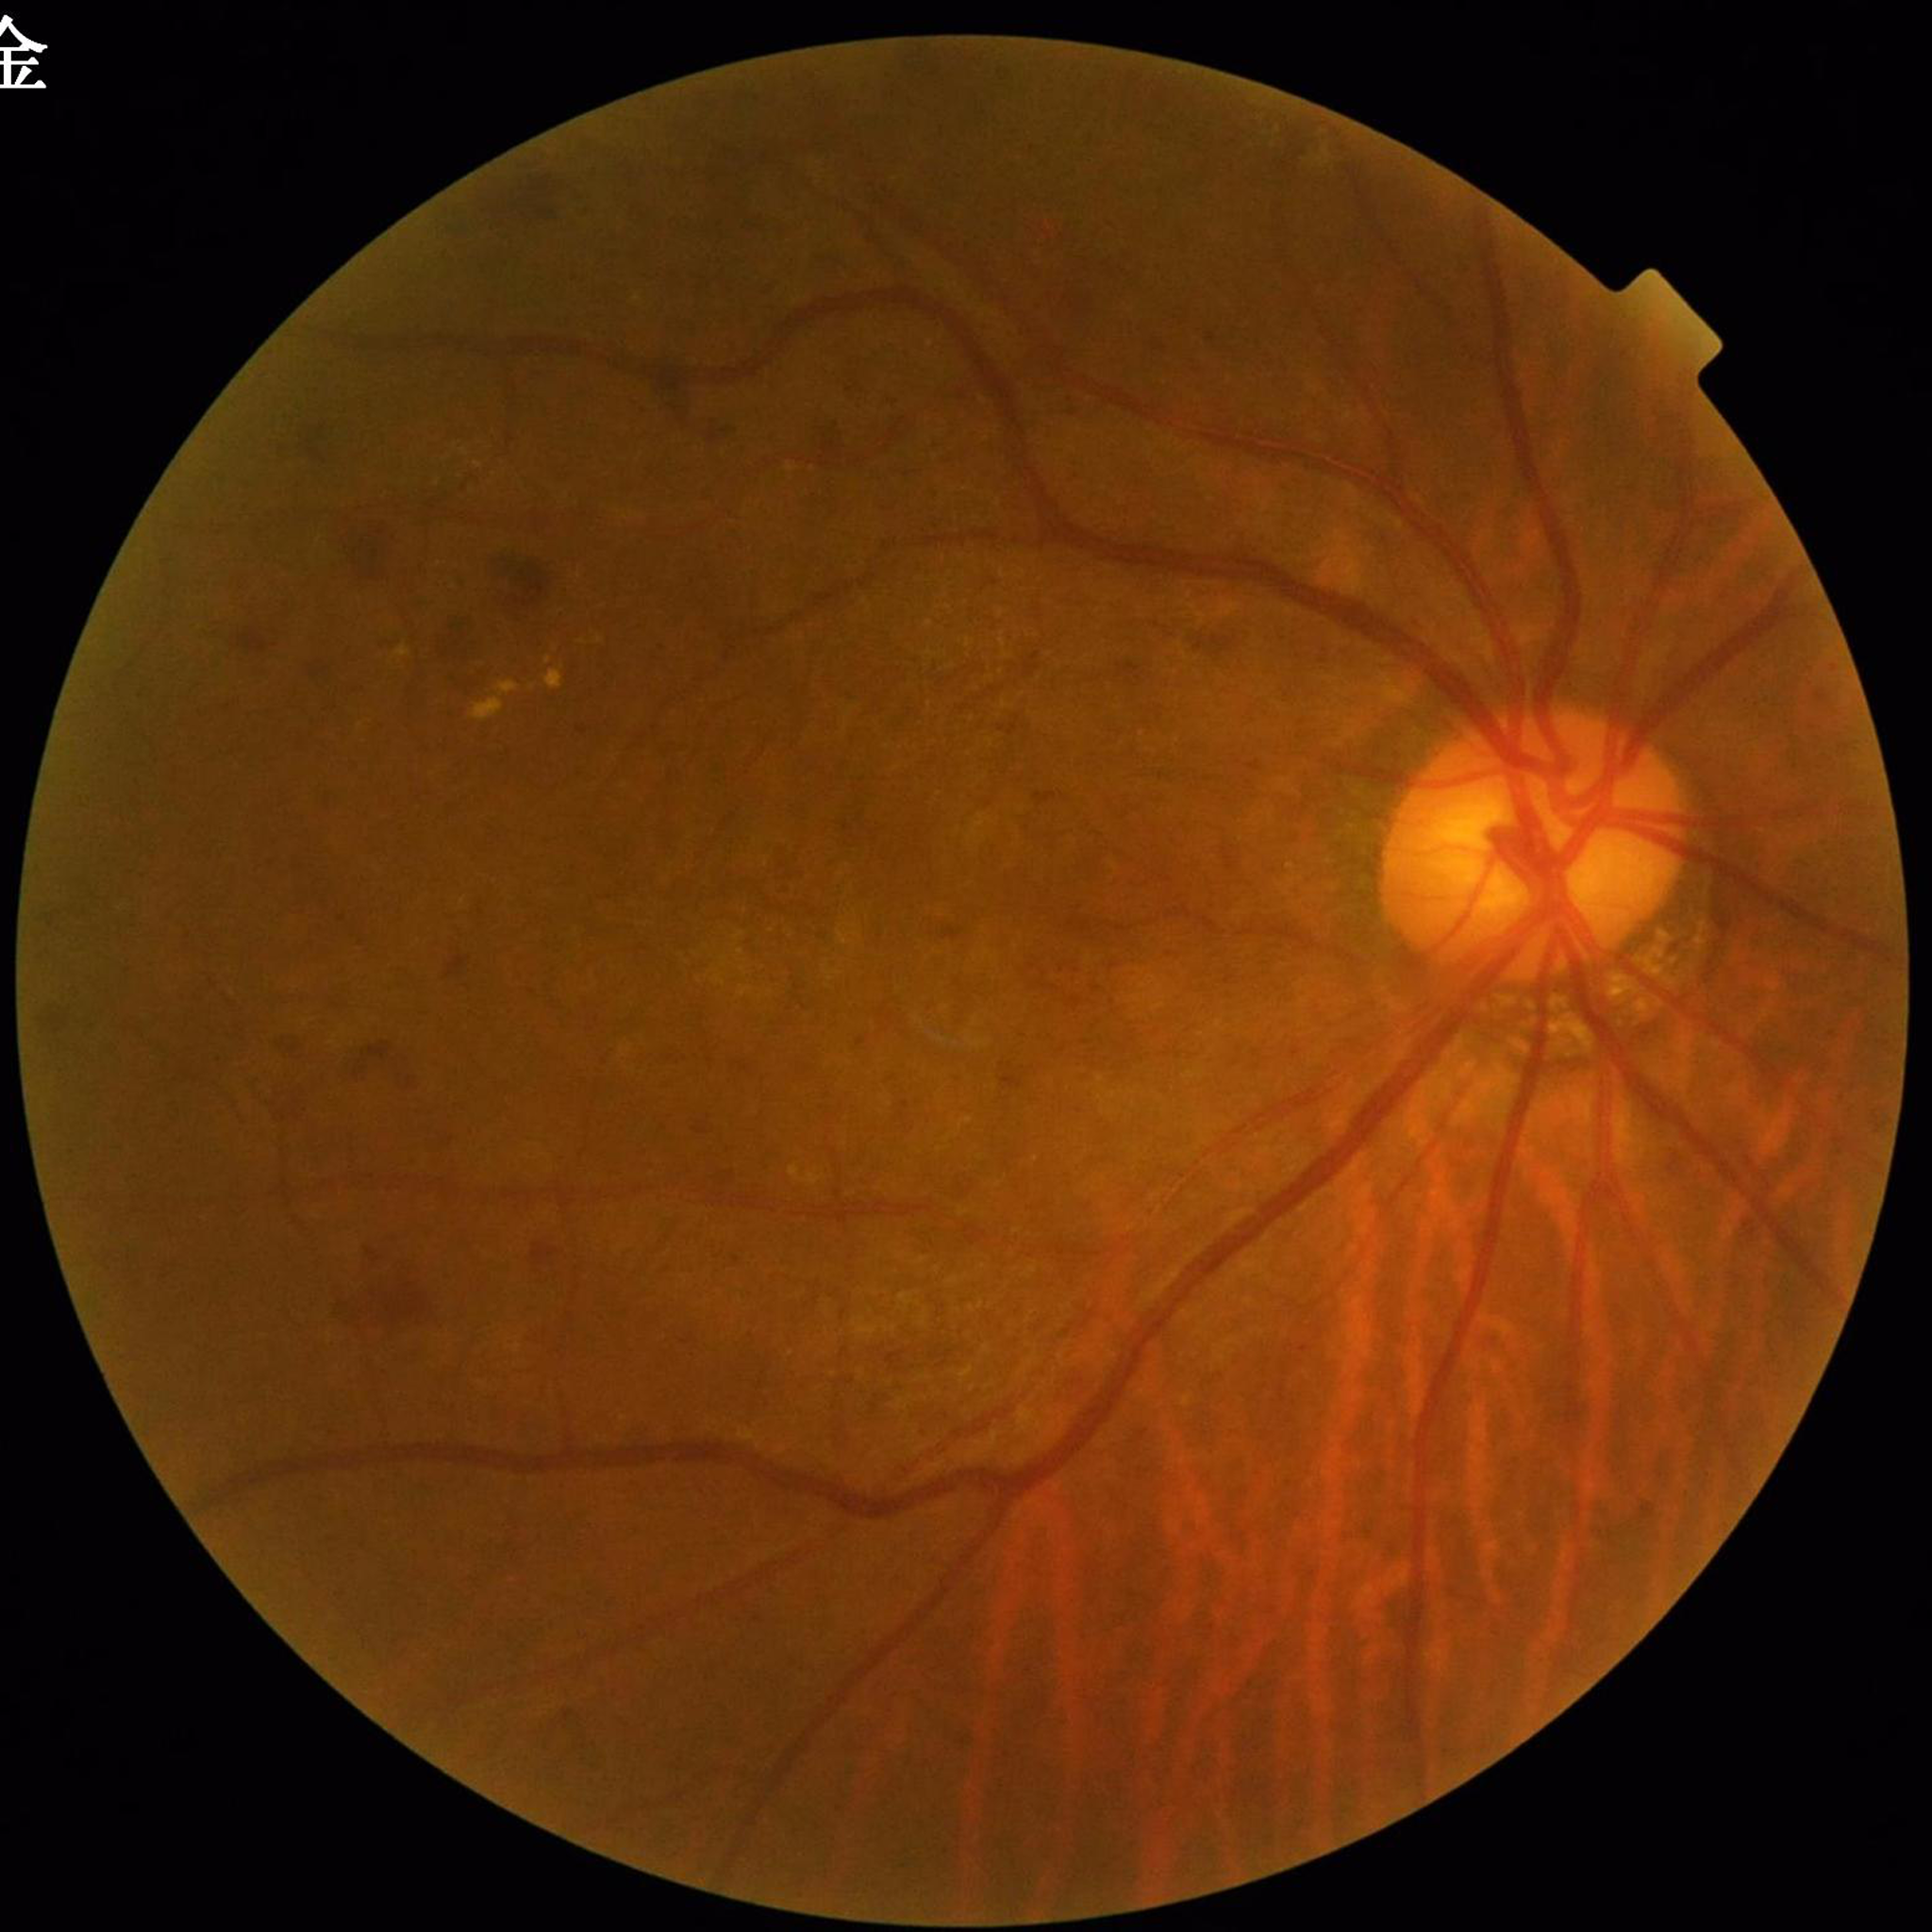 Disease: diabetic retinopathy (DR) | Photo quality: no concerns identified.